Color fundus photograph · 45-degree field of view — 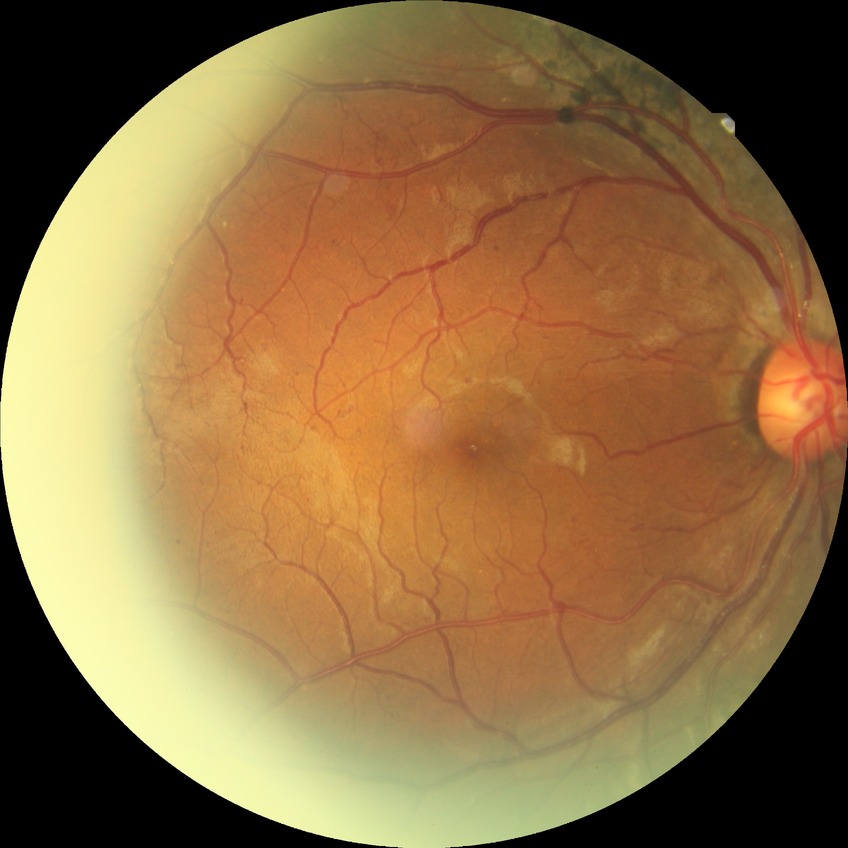 Diabetic retinopathy (DR): pre-proliferative diabetic retinopathy (PPDR).